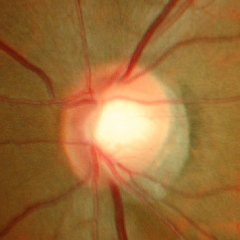 Glaucoma is present. Glaucoma stage = early glaucoma. Diagnostic criteria: glaucomatous retinal nerve fiber layer defects on red-free fundus photography without visual field defects.